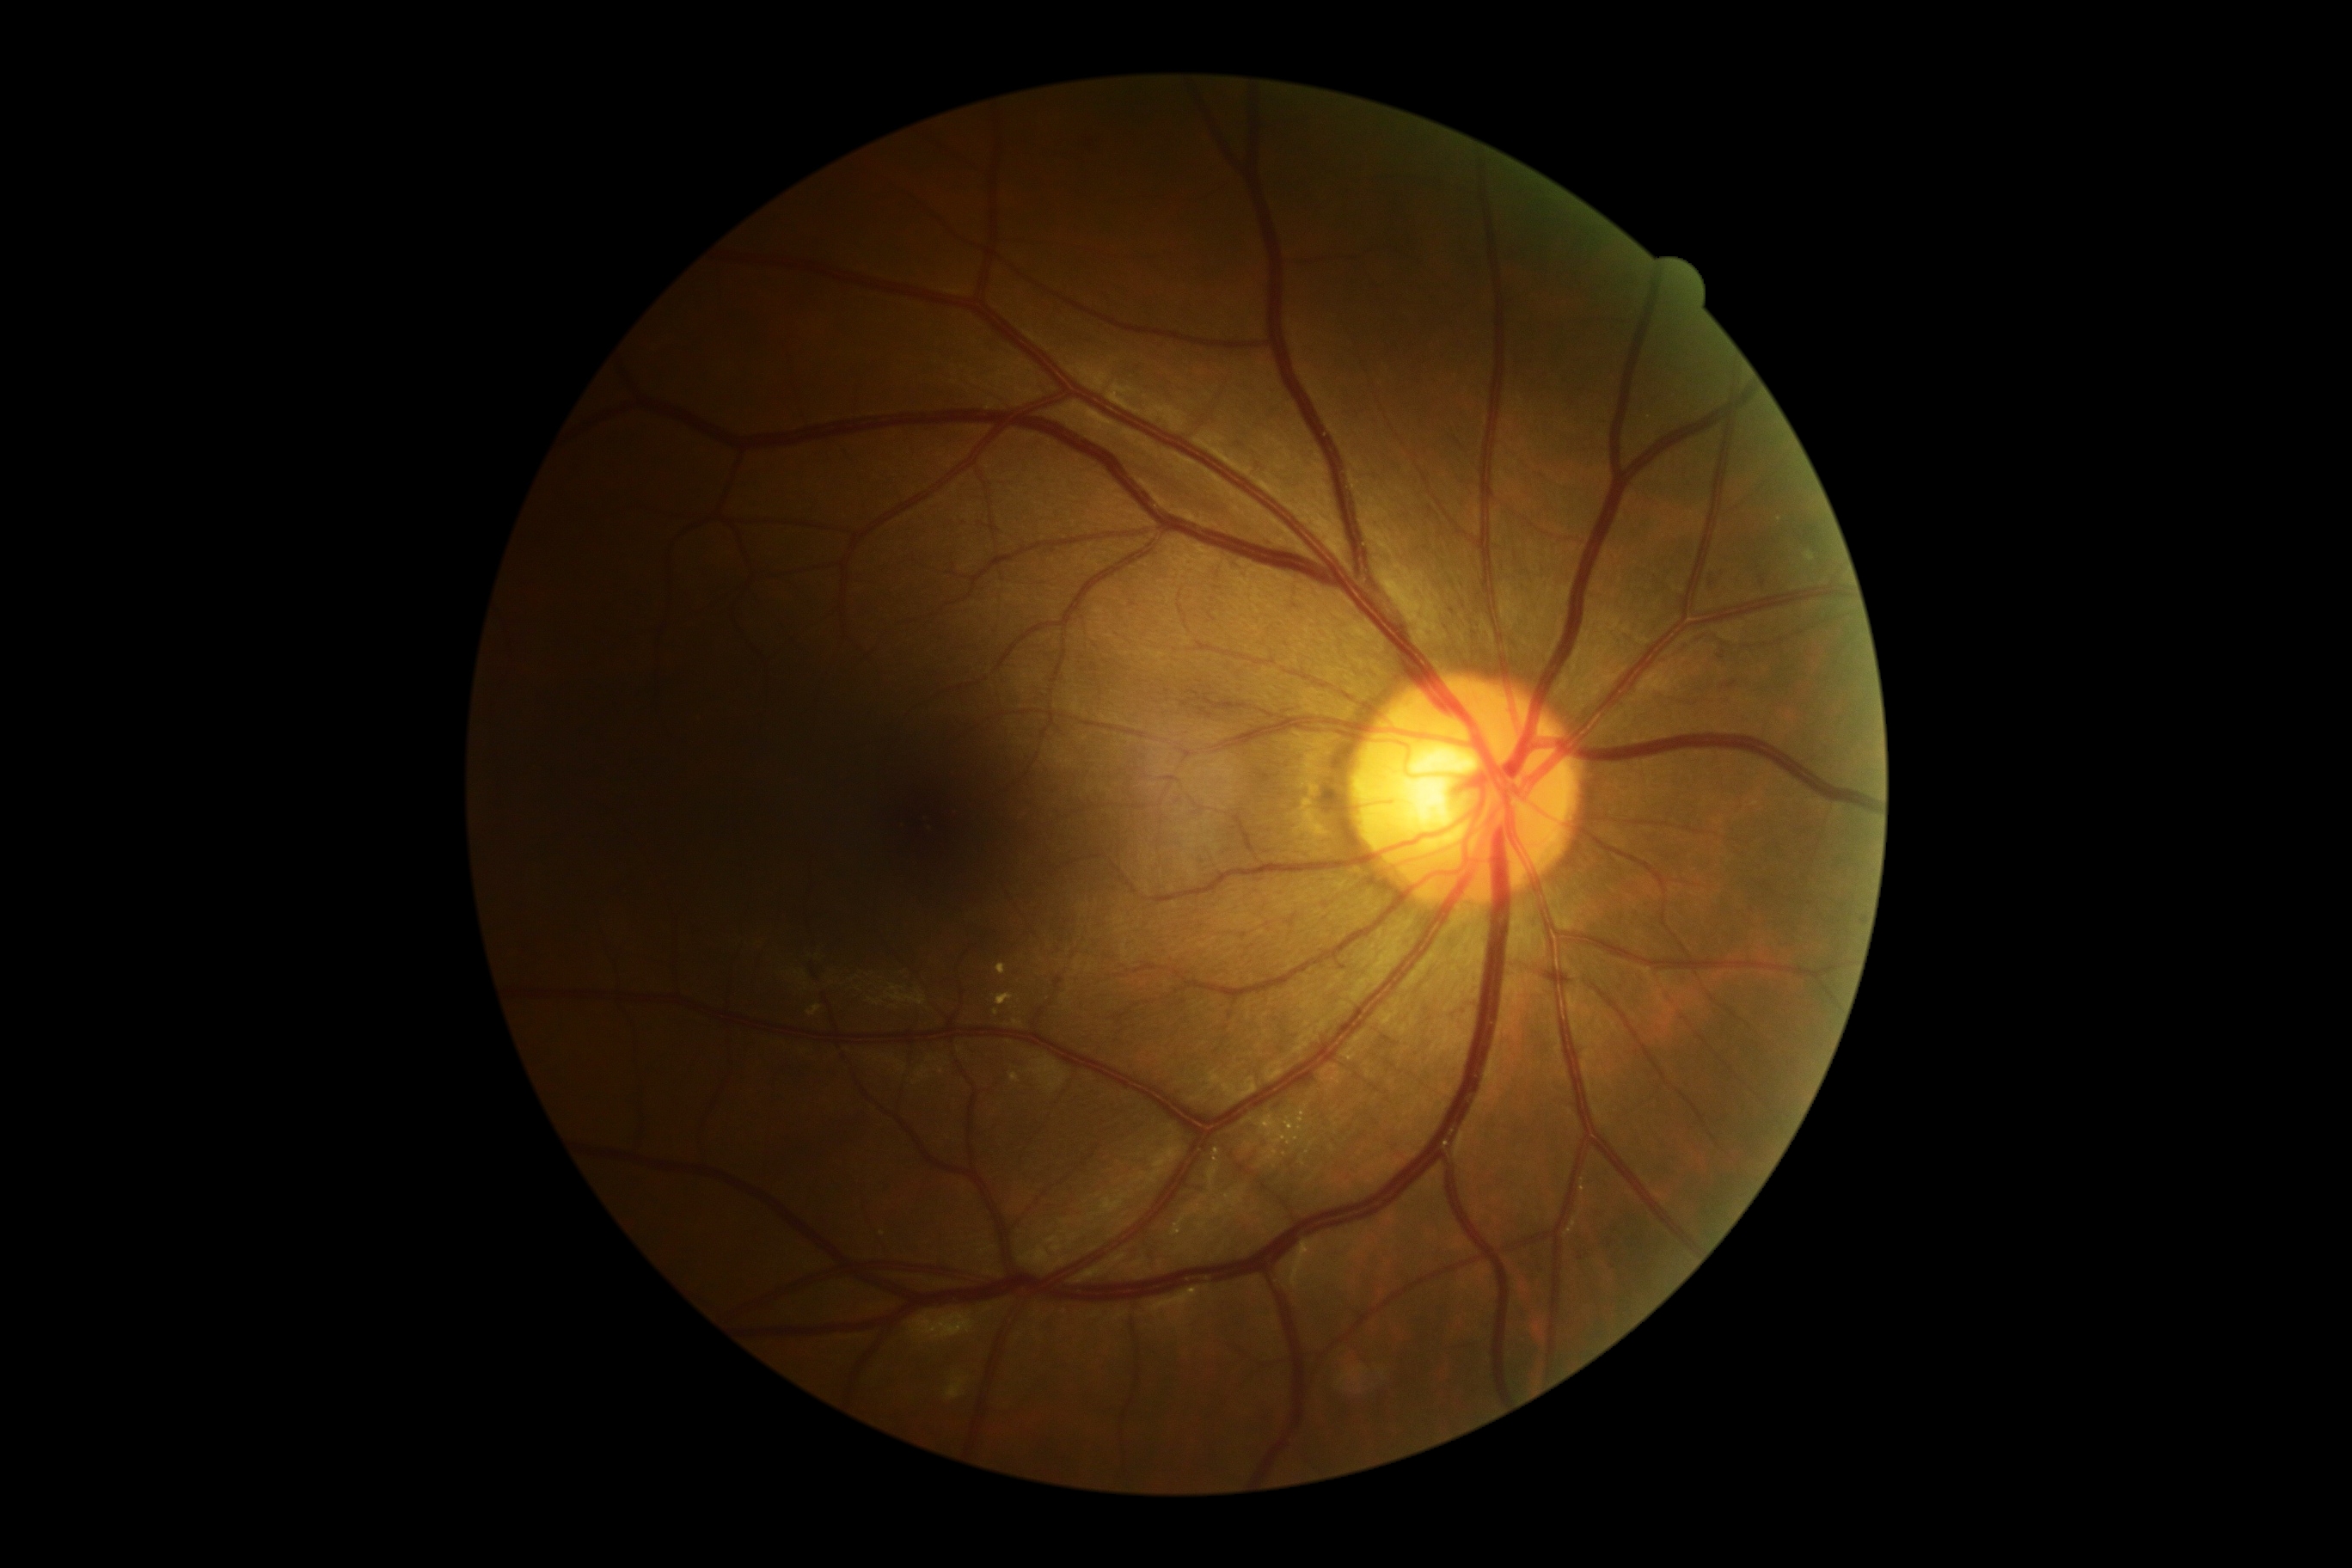

Retinopathy: moderate NPDR (grade 2).